2212 by 1659 pixels; fundus photo: 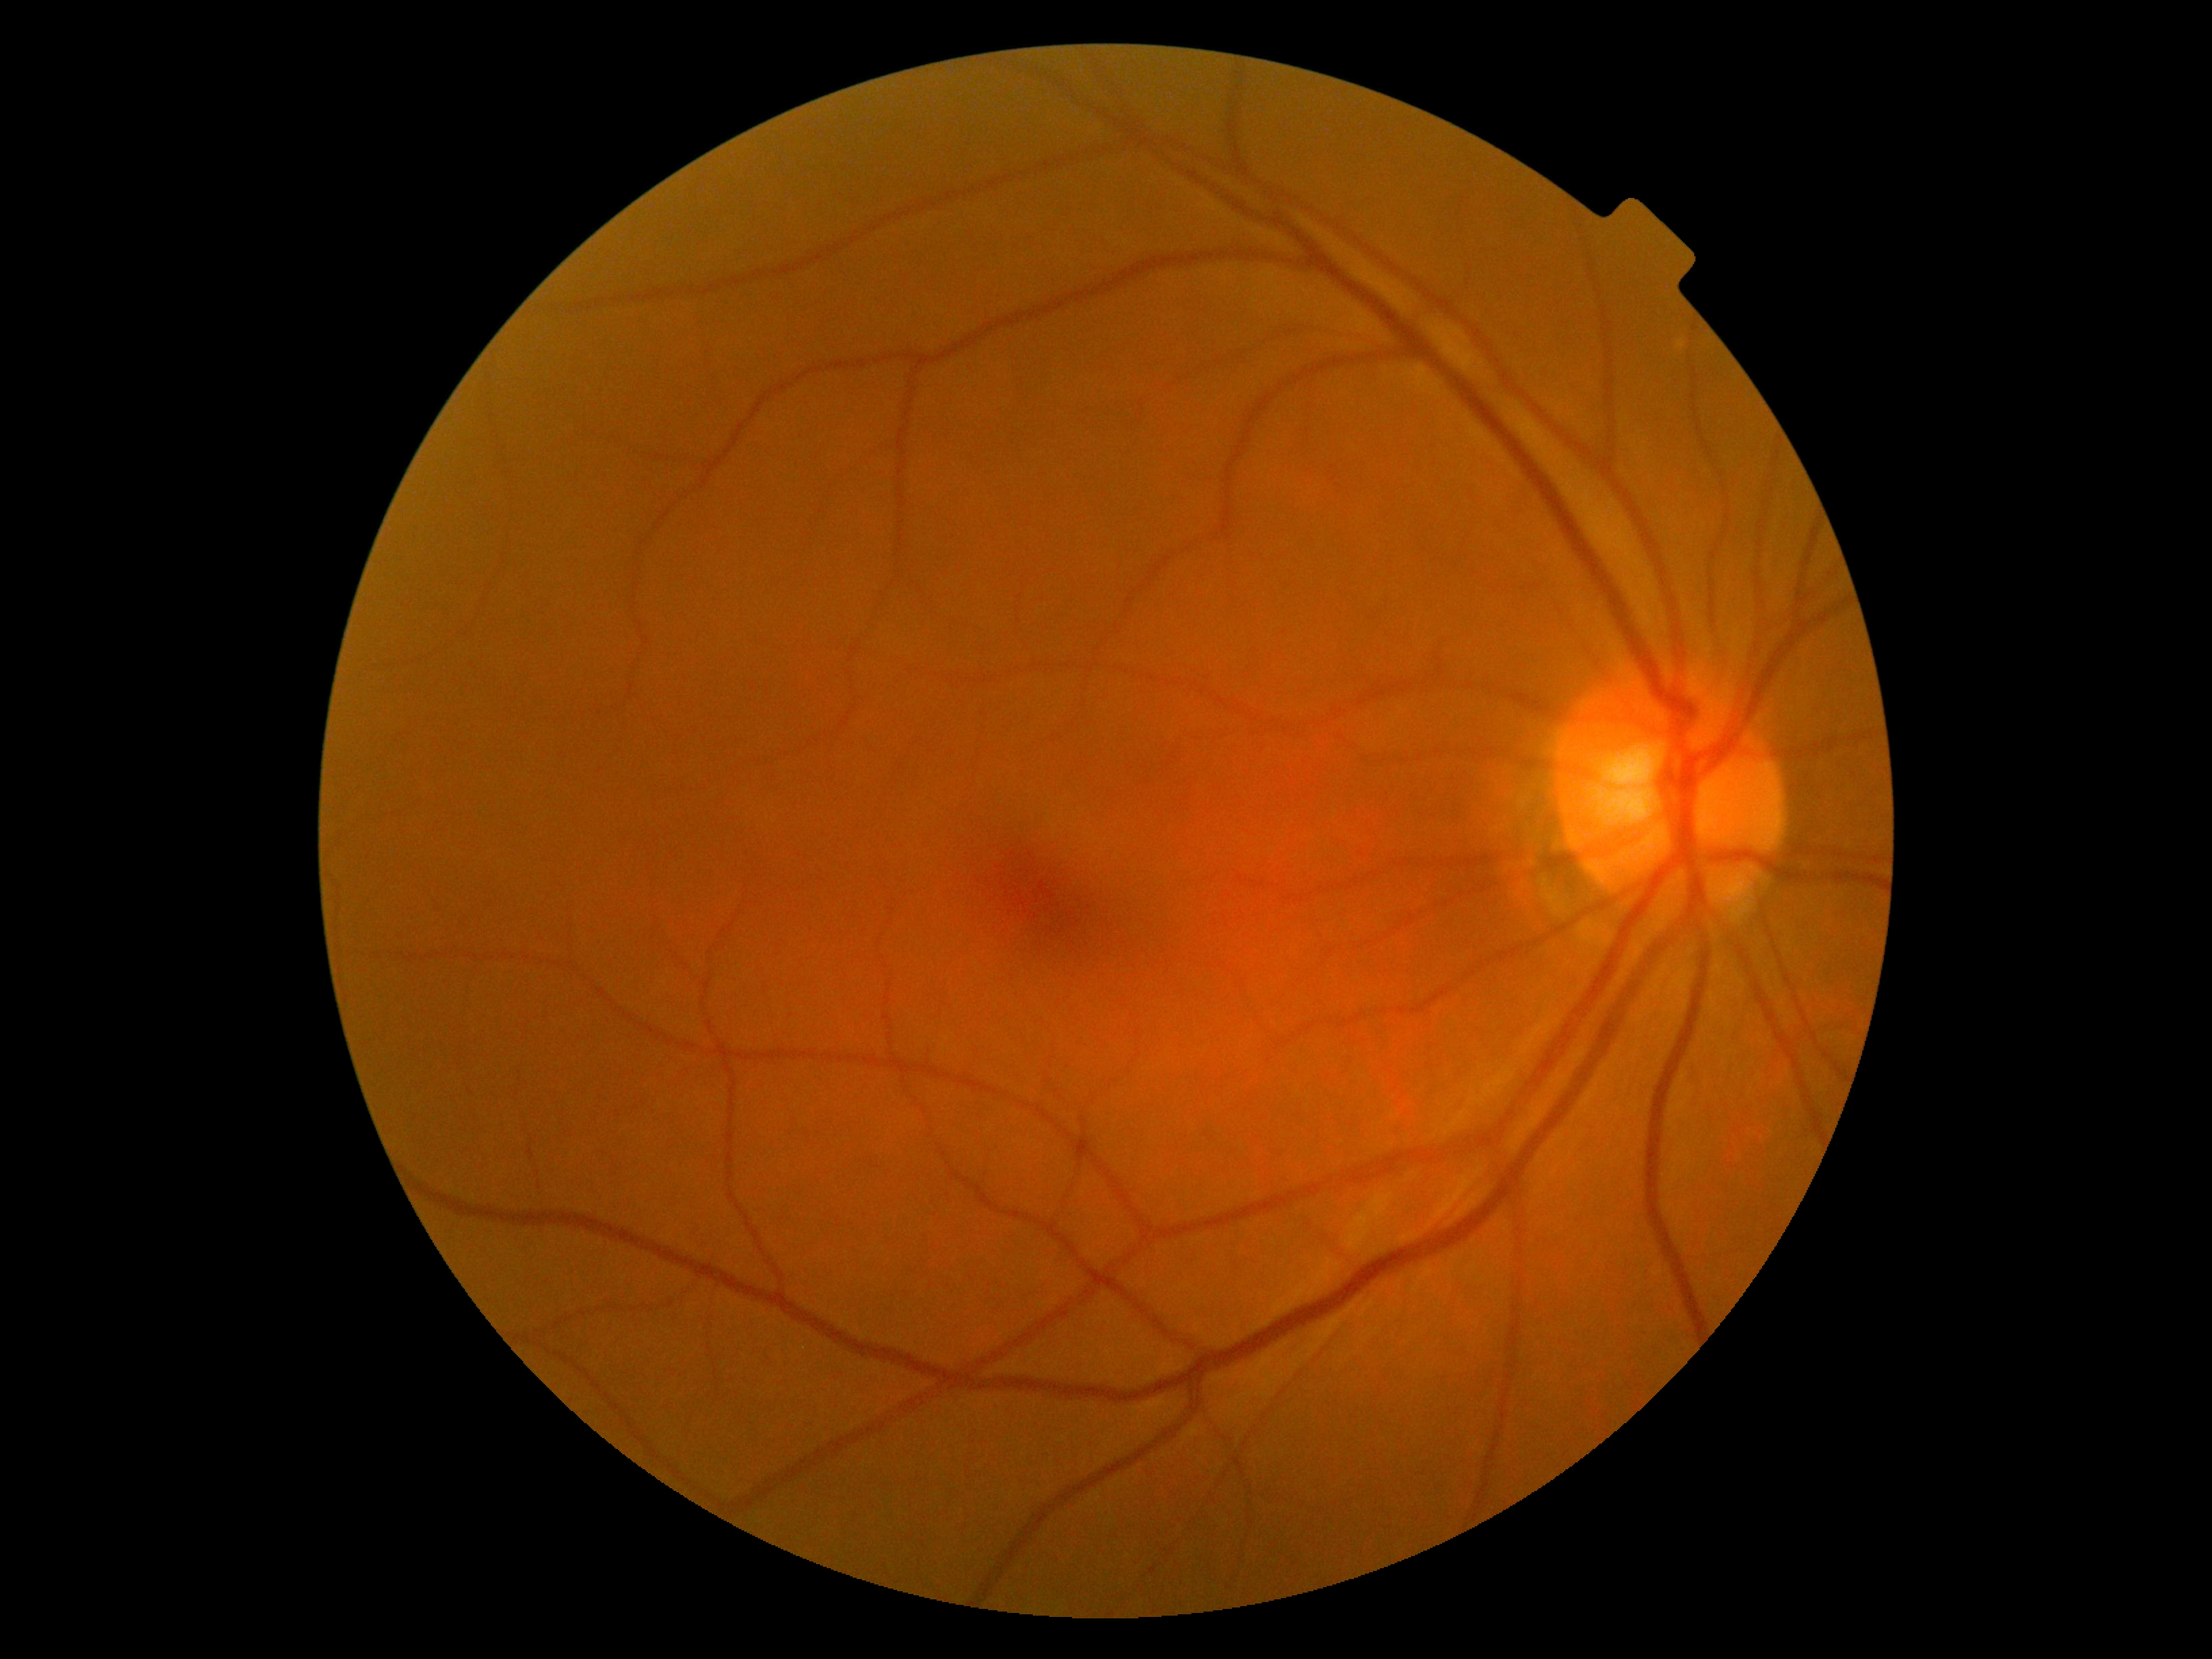 DR severity is grade 0 (no apparent retinopathy).